Color fundus image · 2352x1568px — 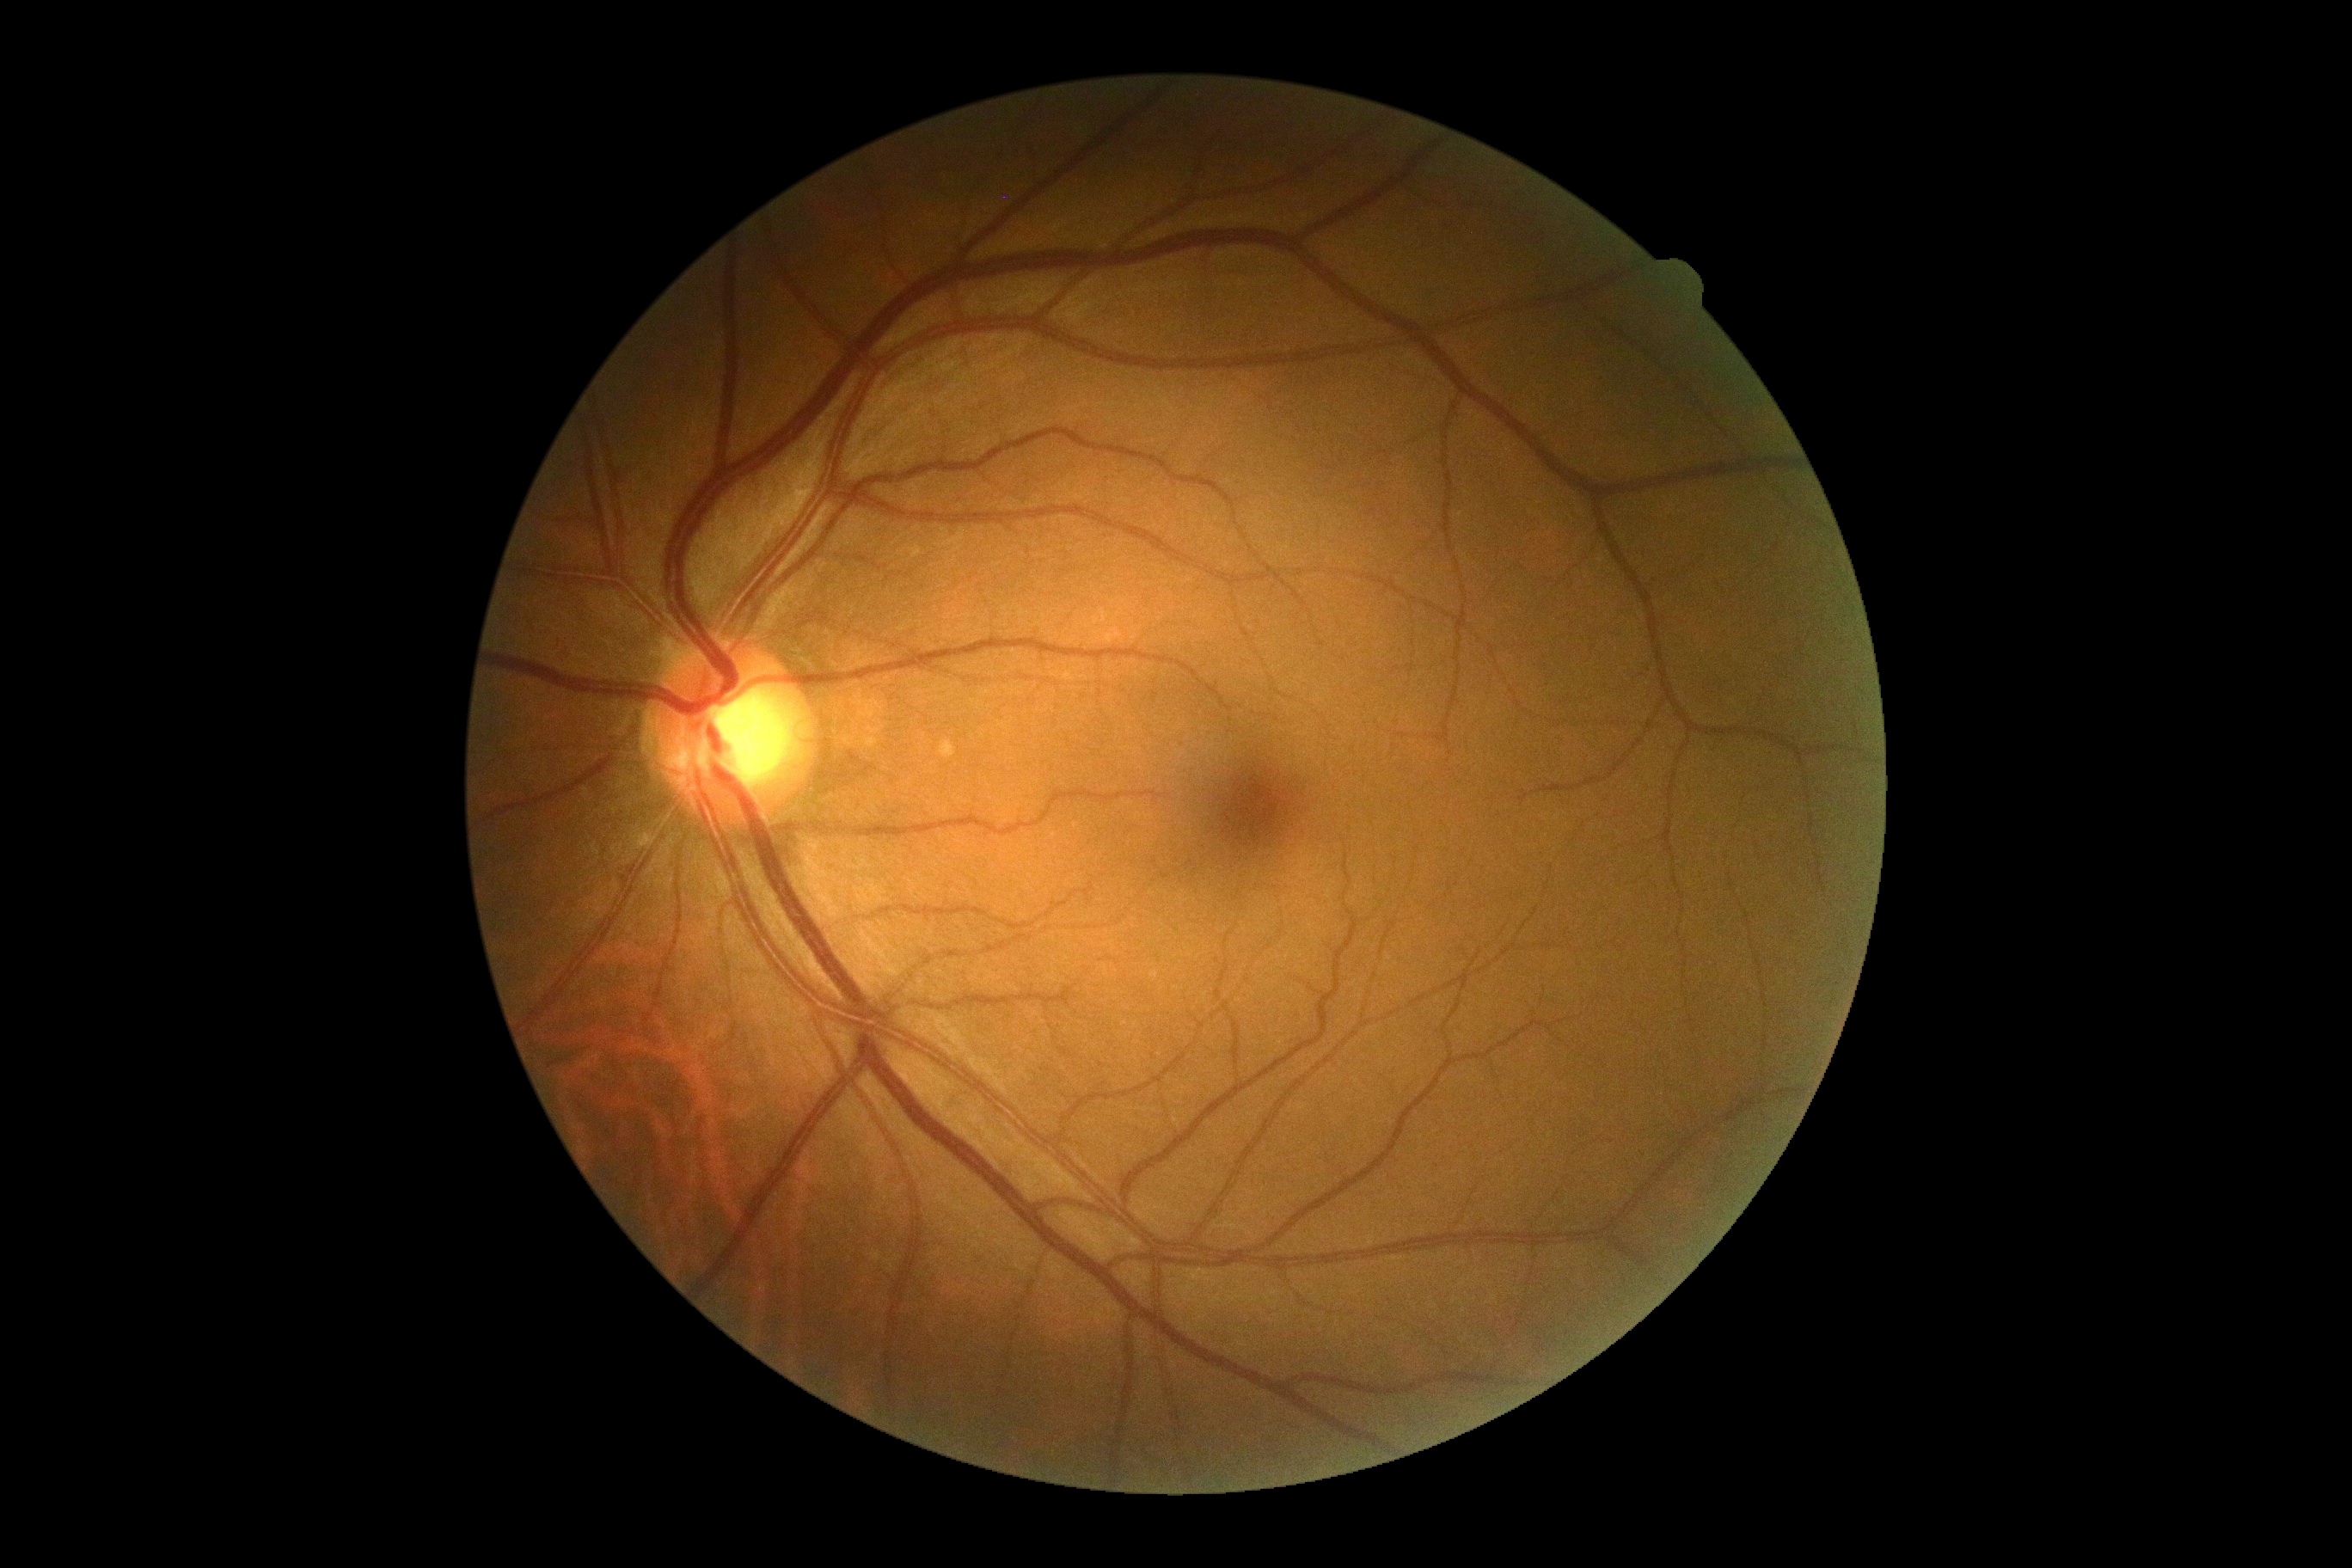

Annotations:
• DR impression — no apparent DR
• retinopathy grade — 0 (no apparent retinopathy)